2089 x 1764 pixels · color fundus image — 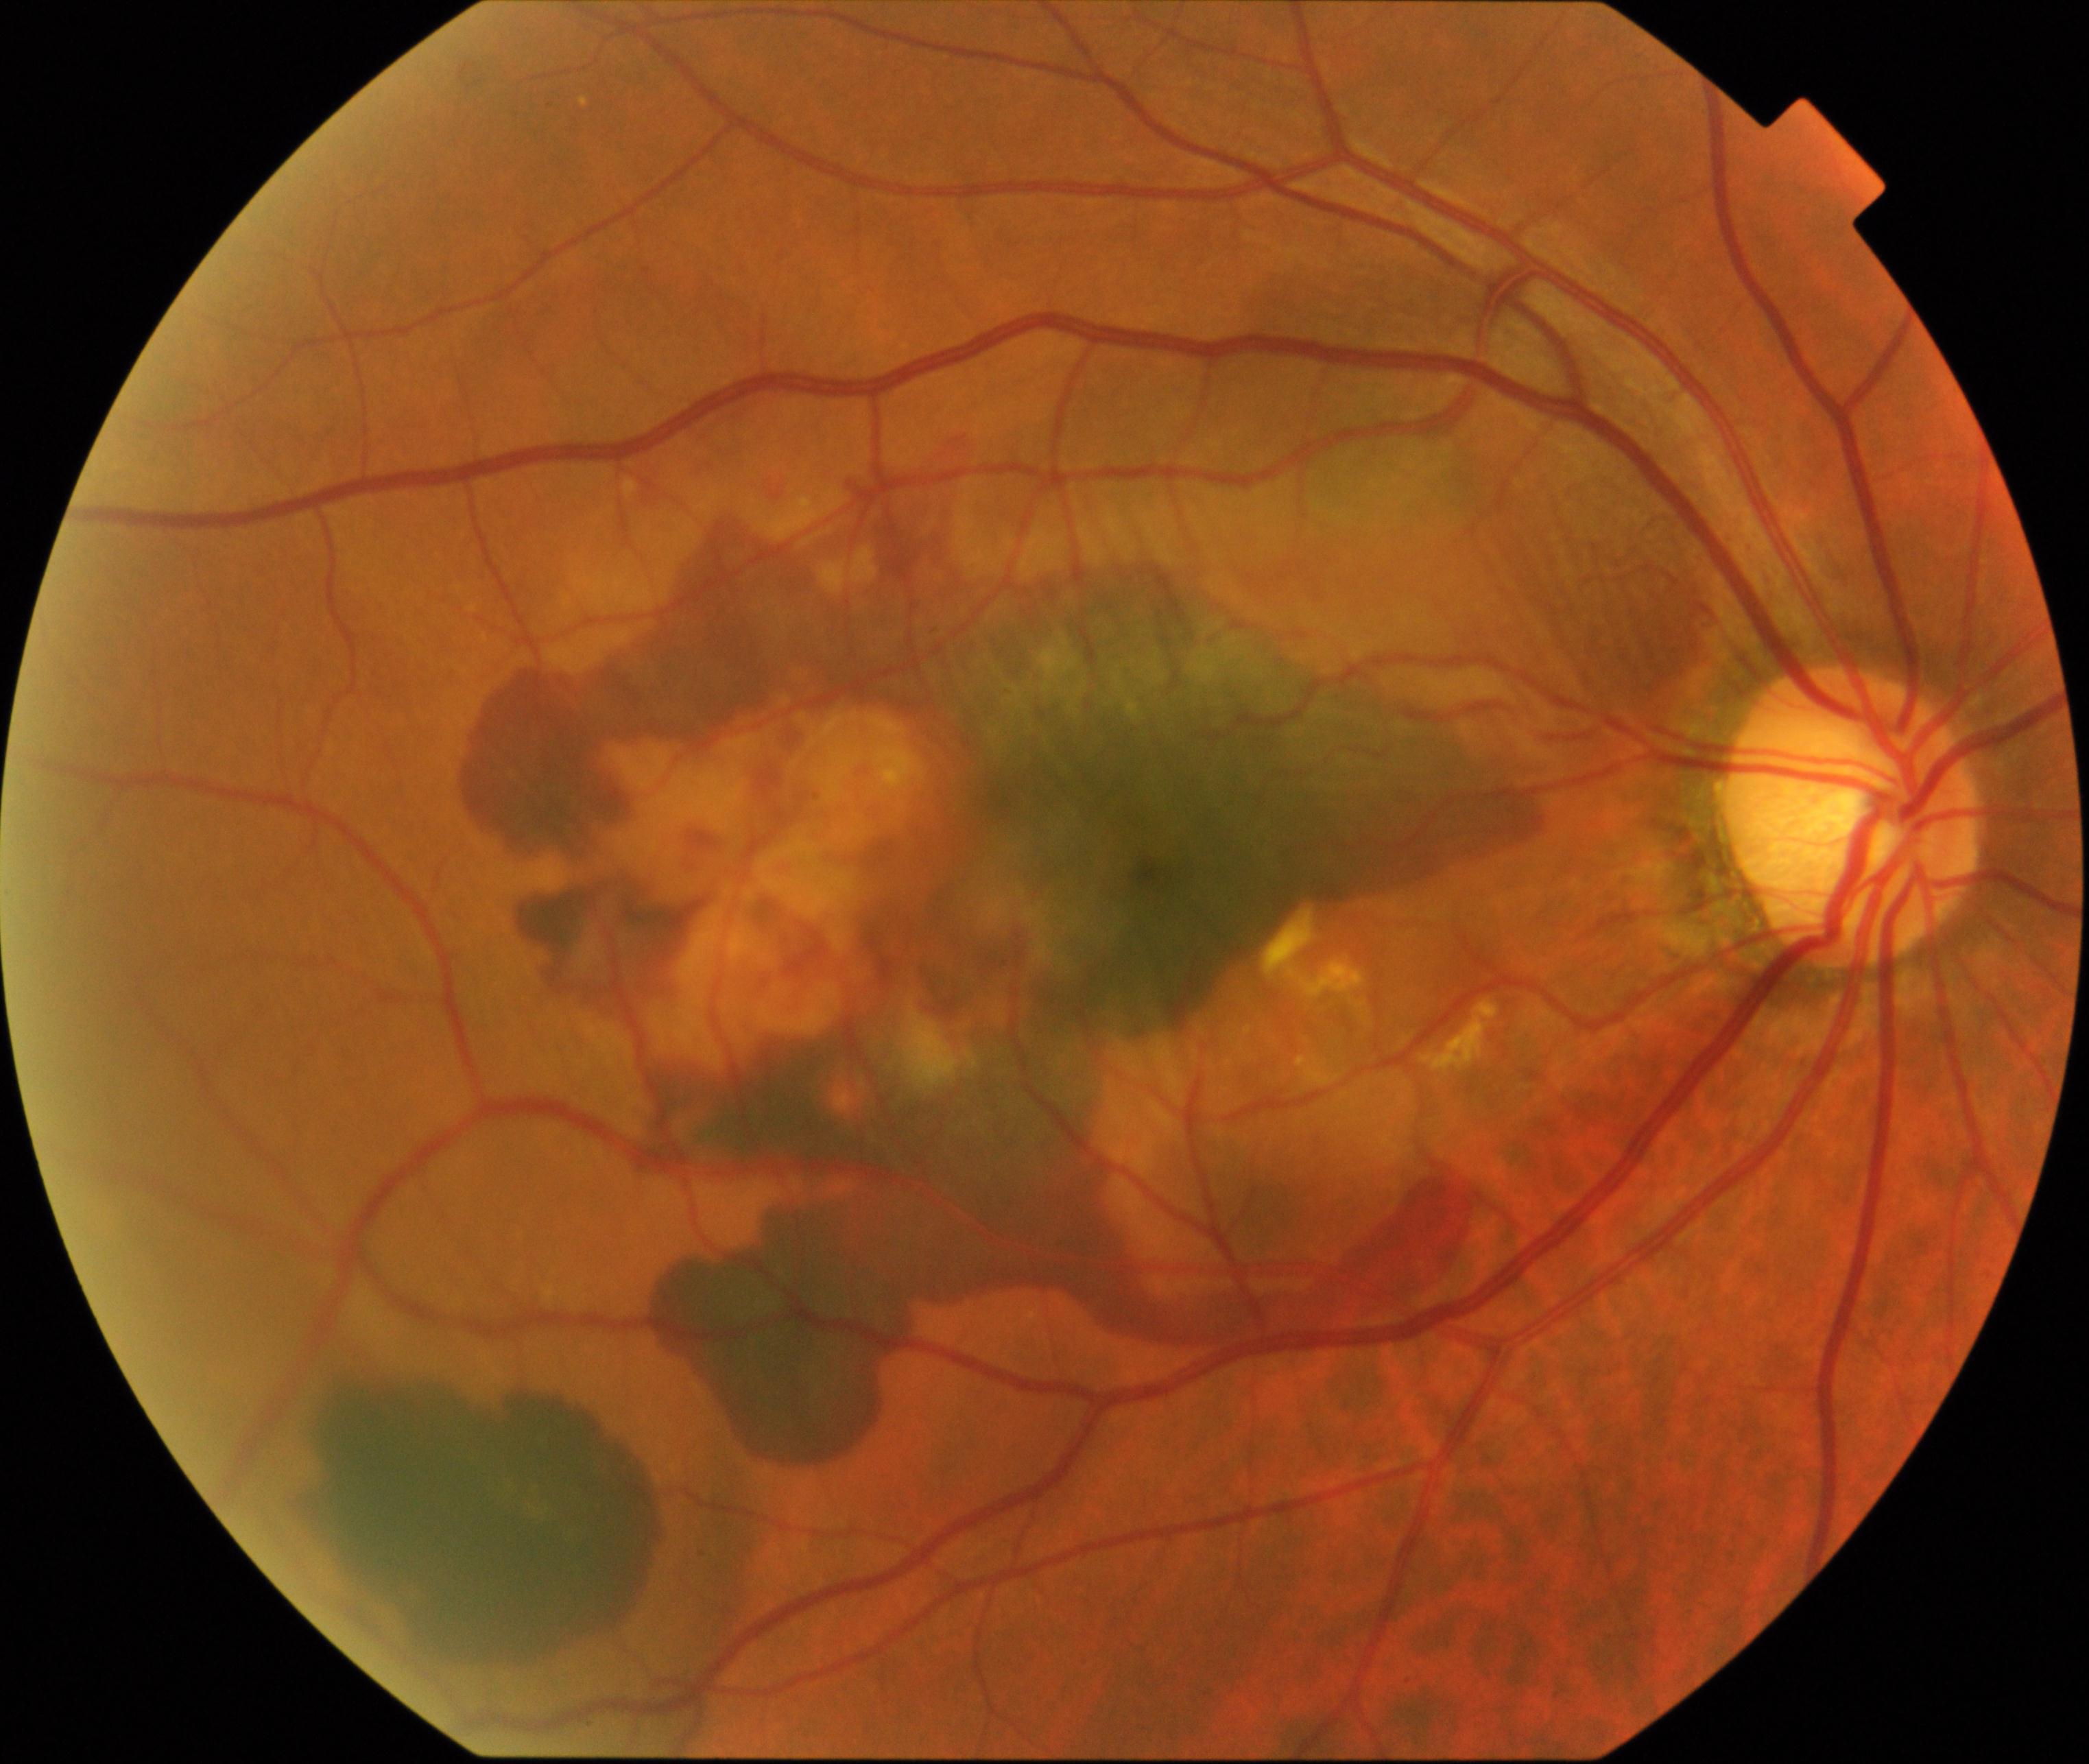 Classification: maculopathy.